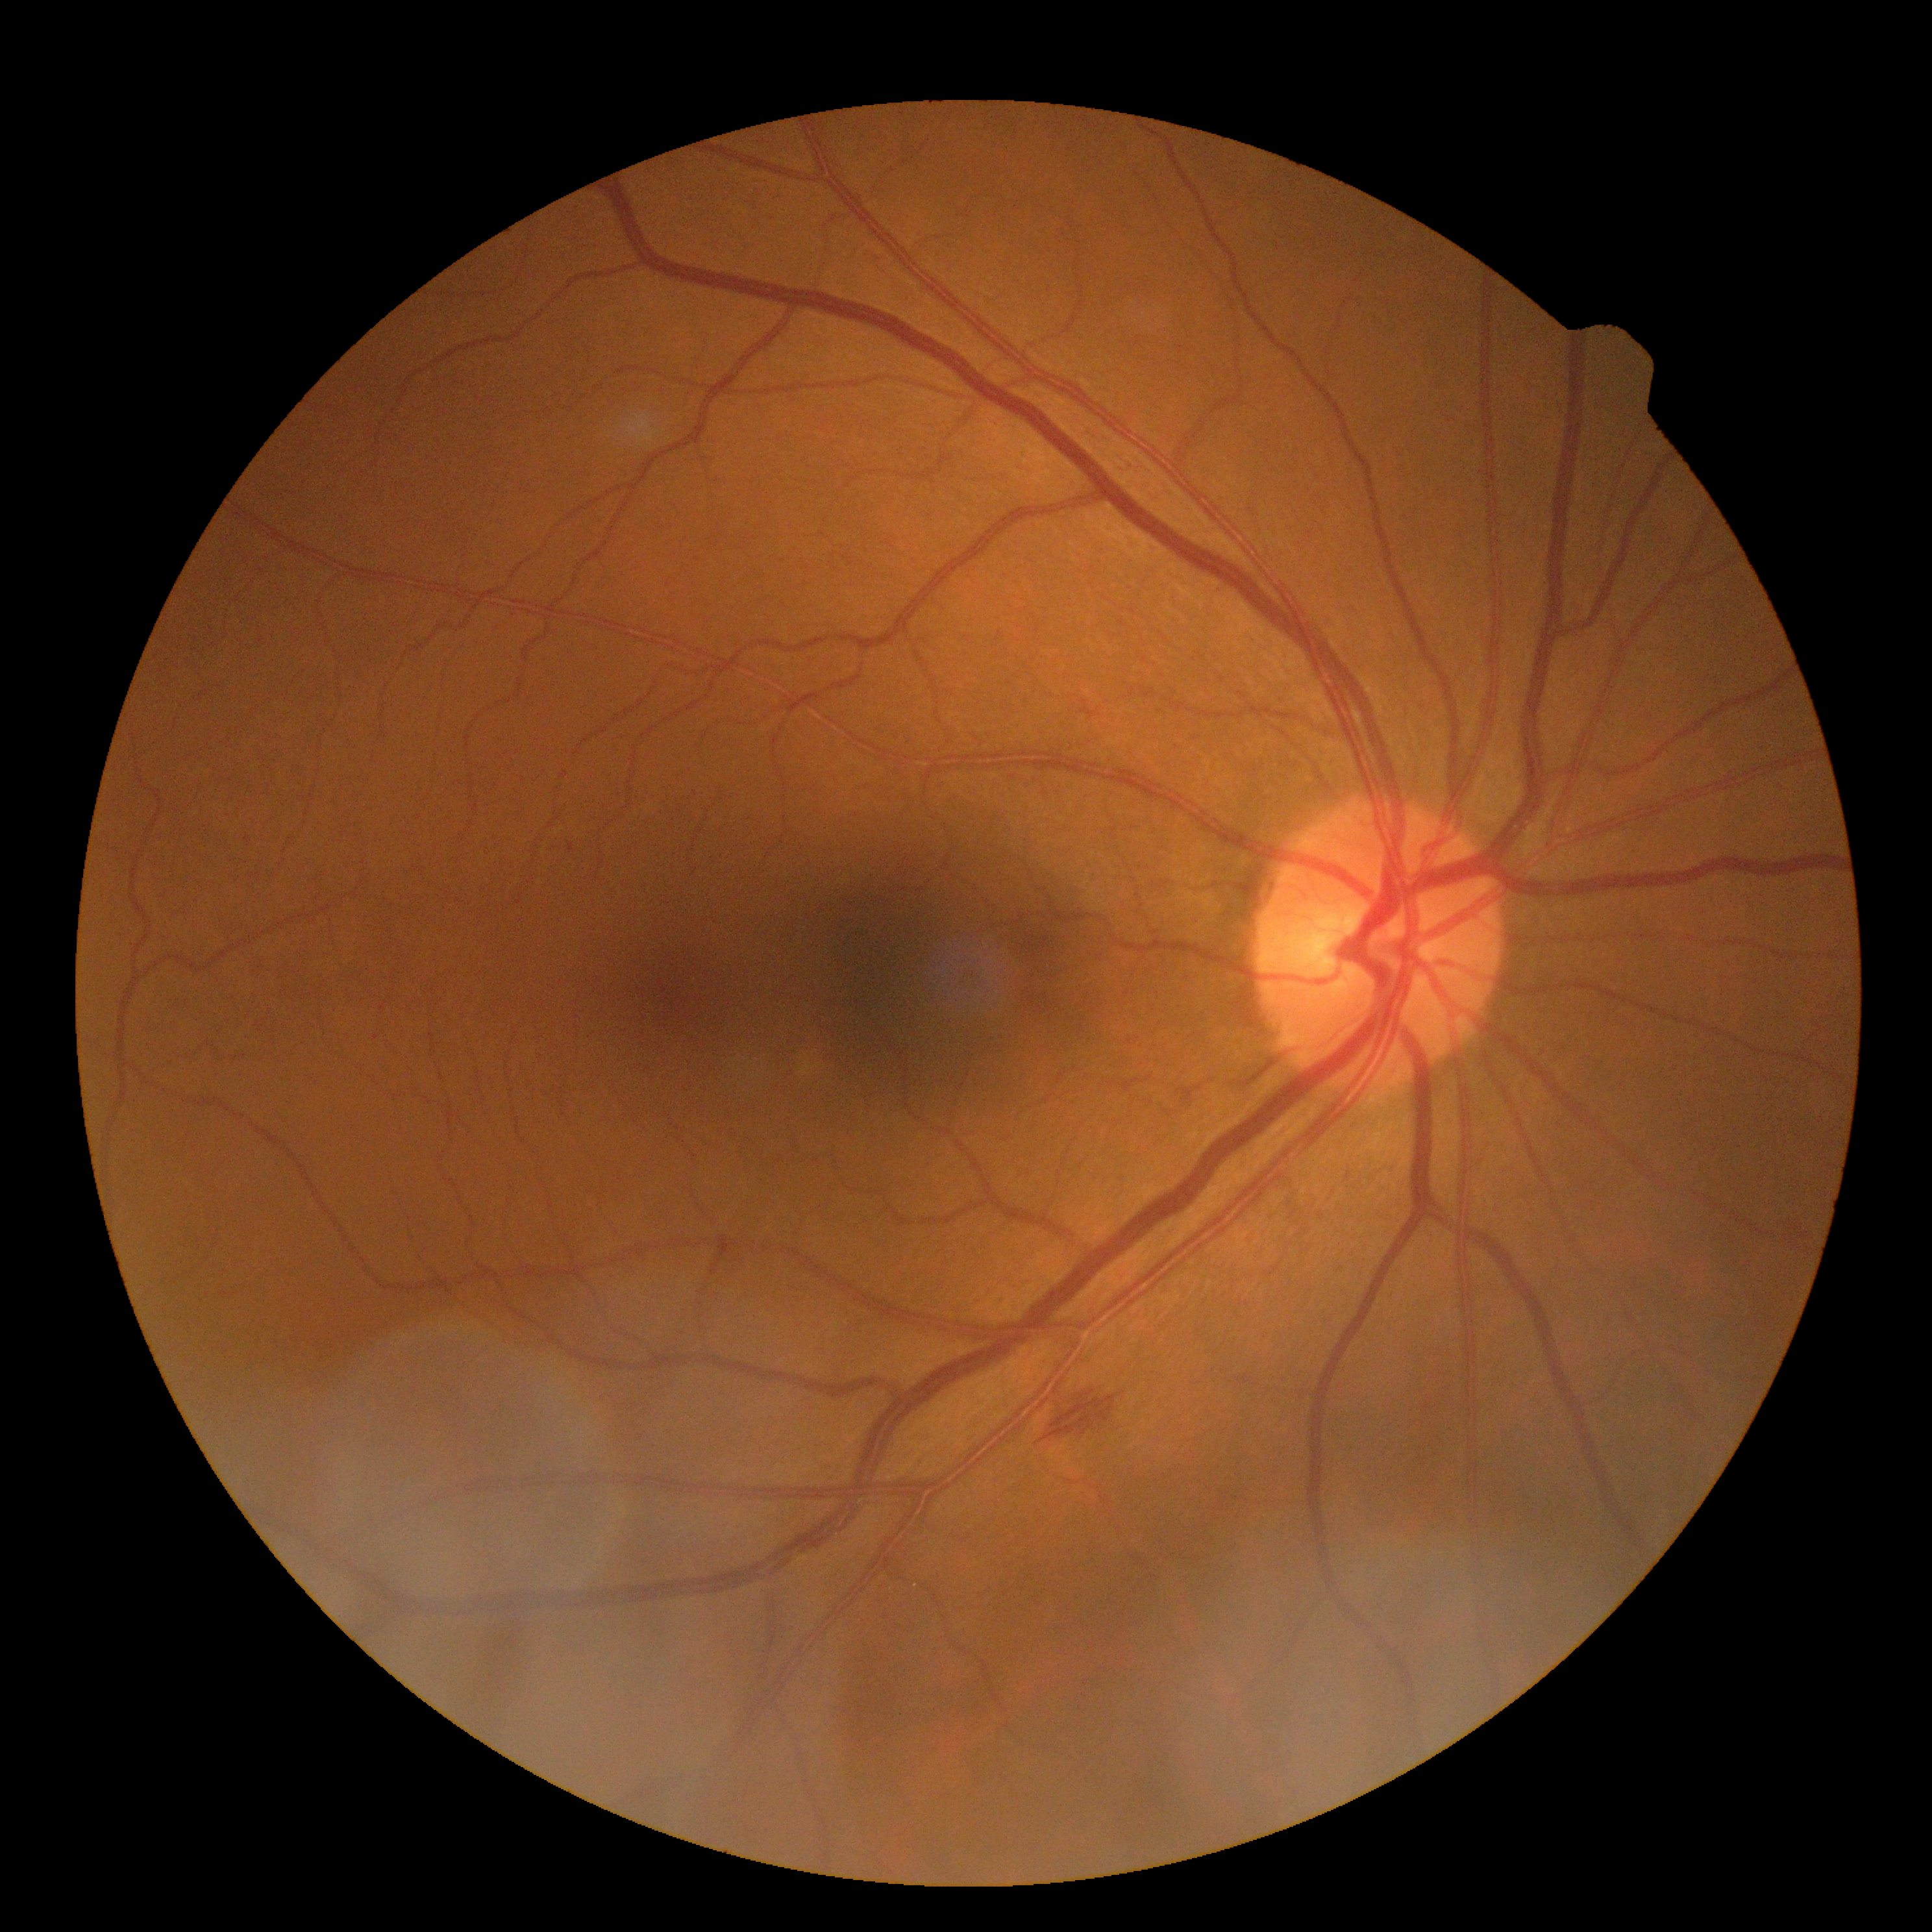 DR class: non-proliferative diabetic retinopathy
DR grade: 2